45° FOV
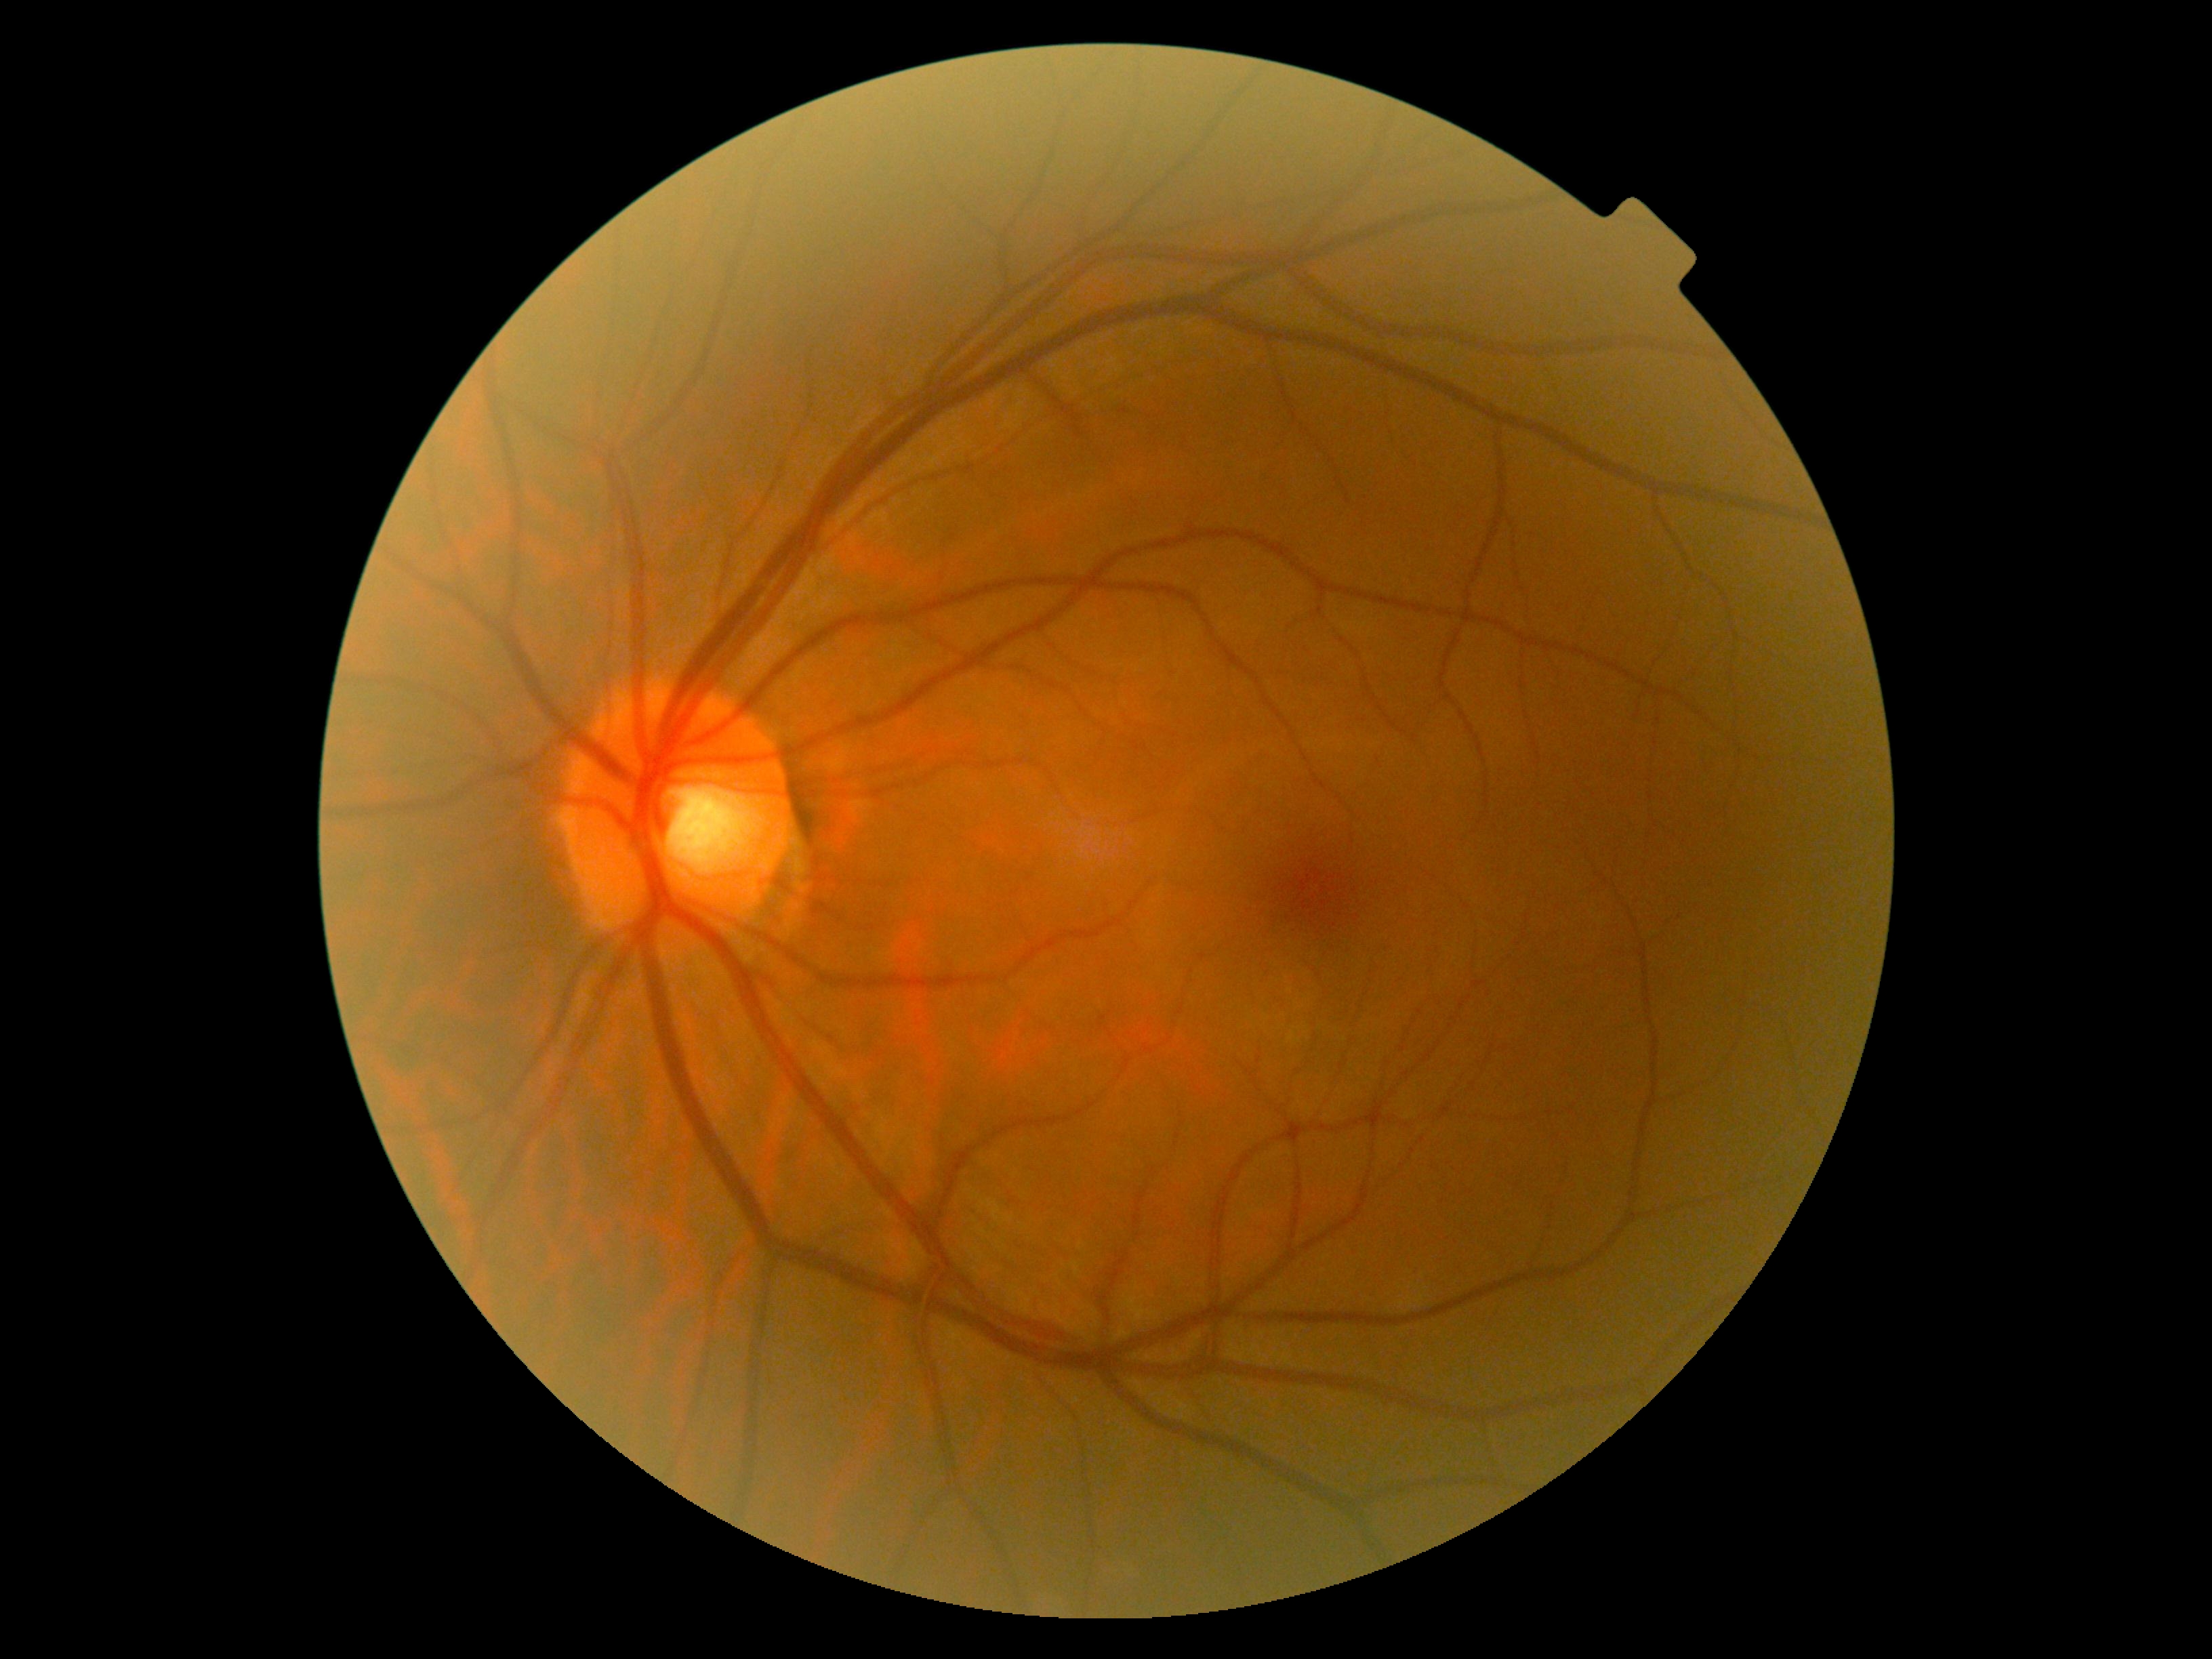

Diabetic retinopathy: no apparent diabetic retinopathy (grade 0).
No apparent diabetic retinopathy.